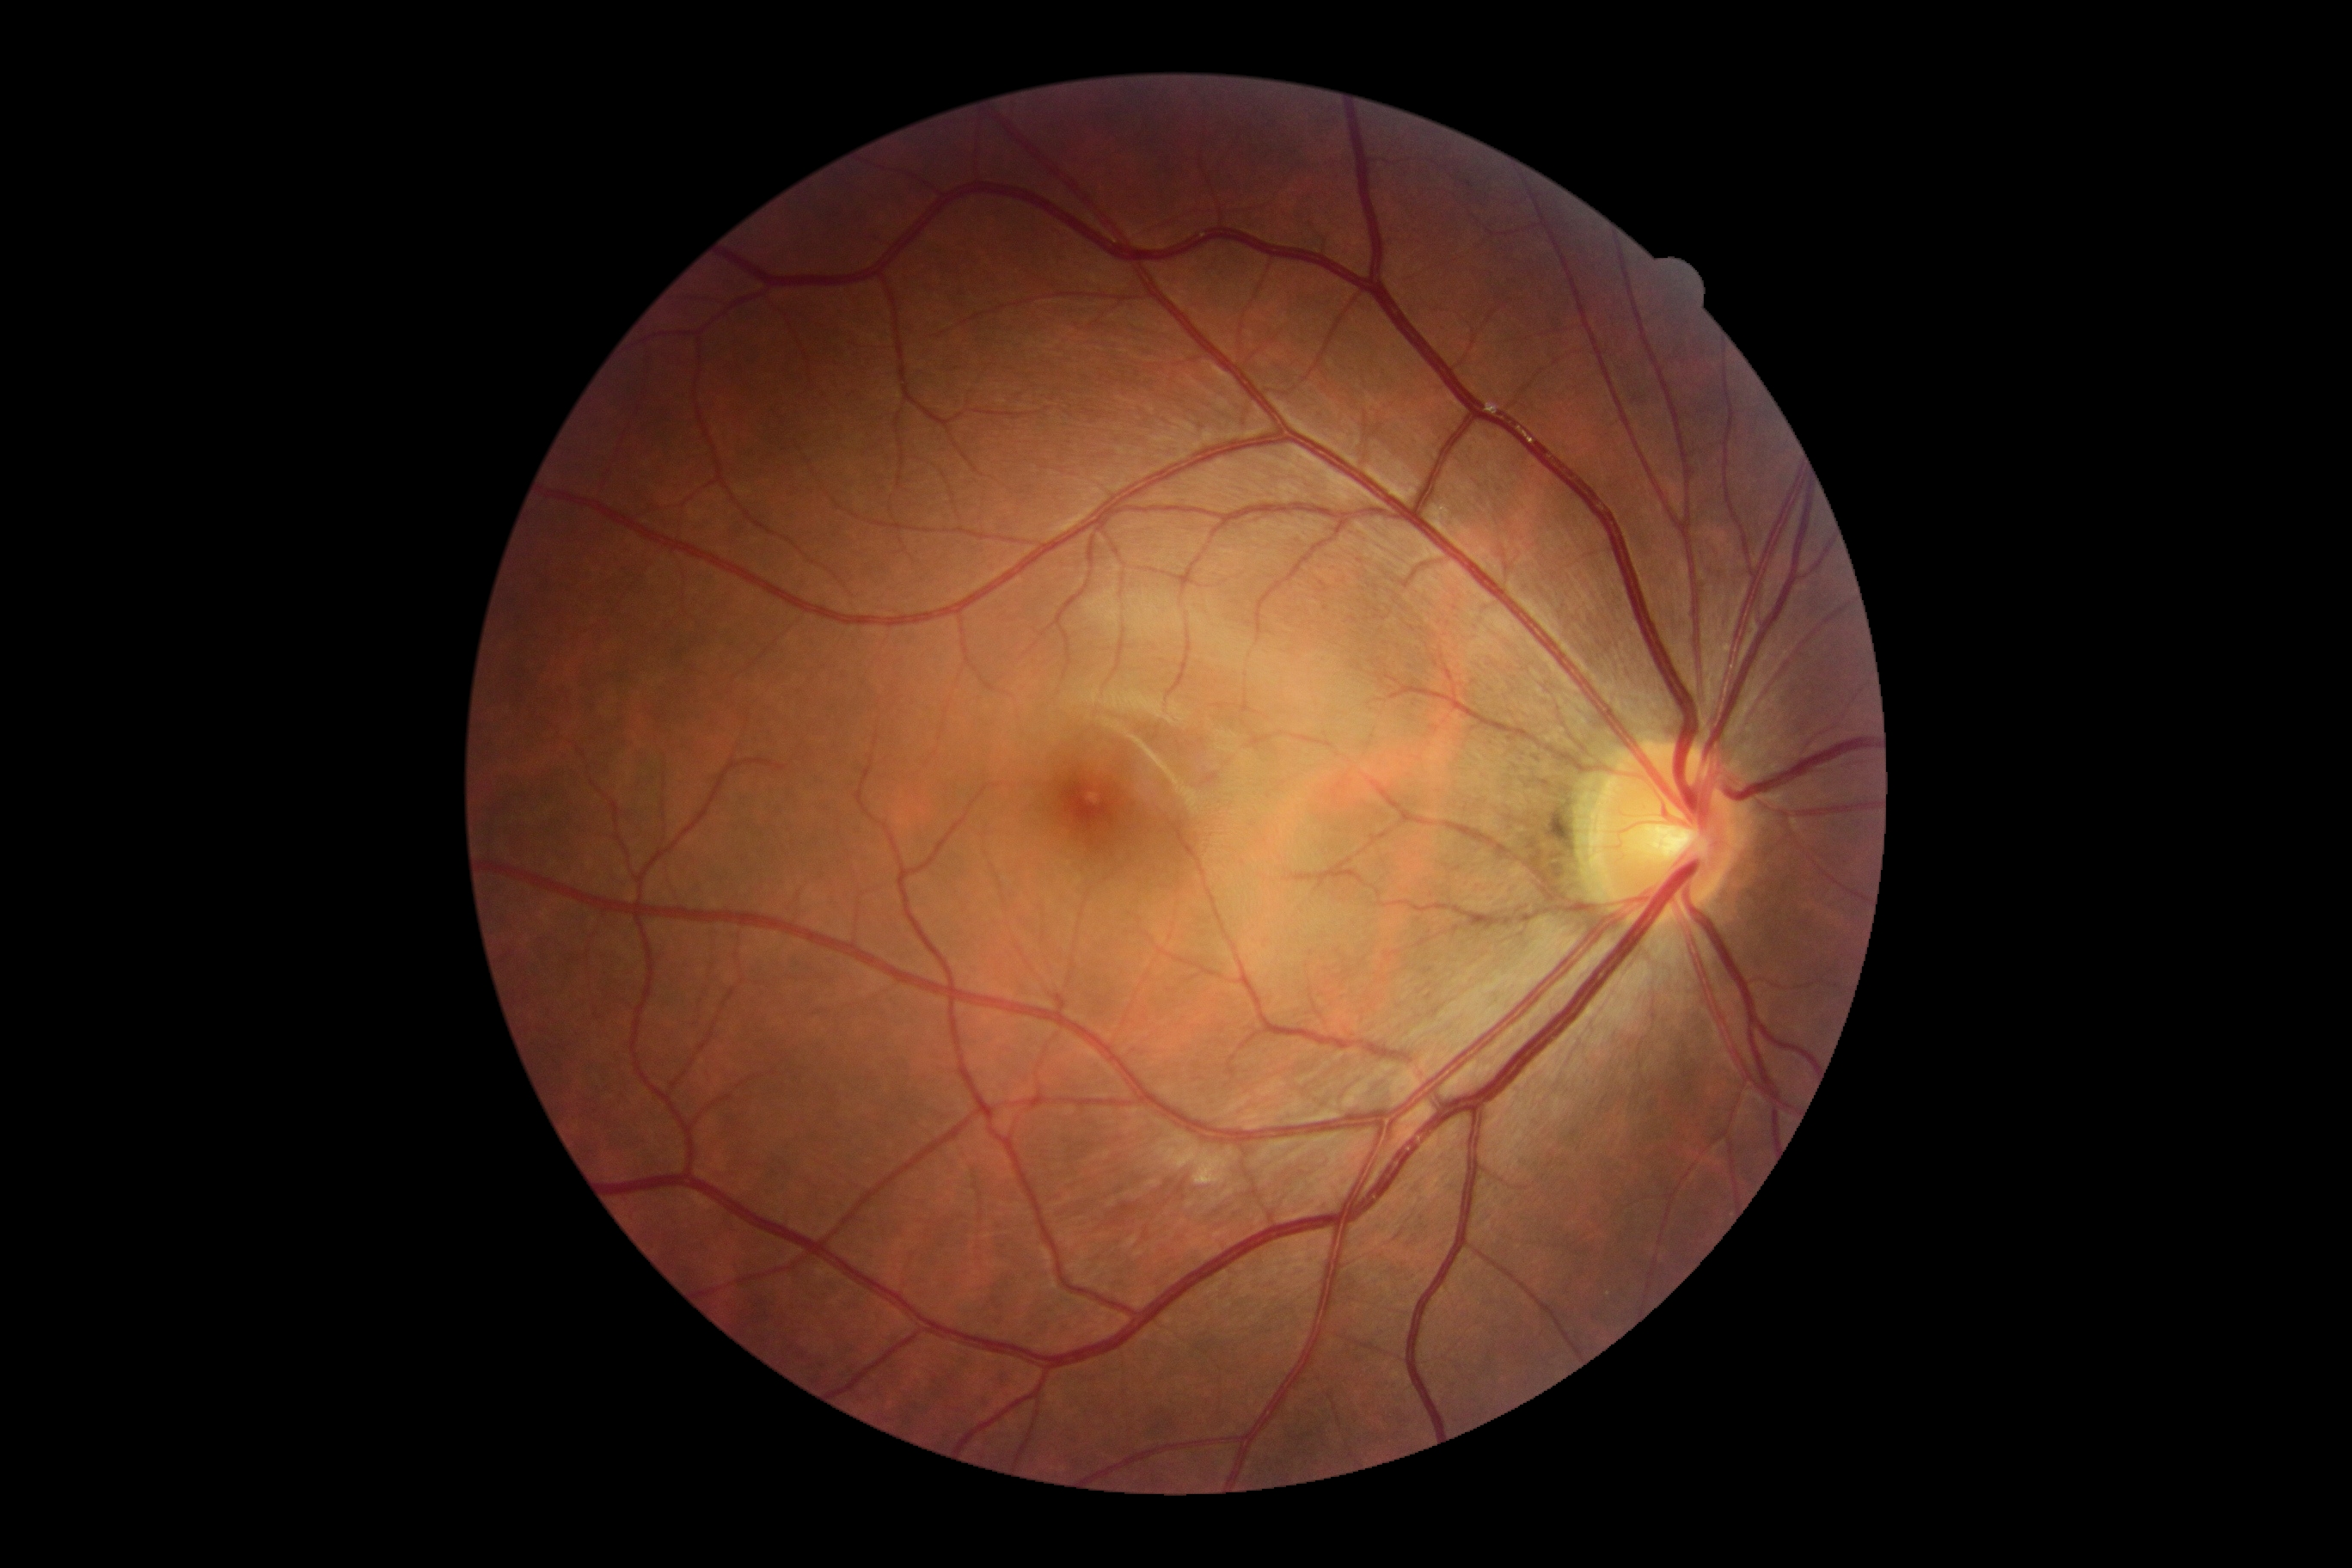 DR severity: 0/4